Color fundus photograph.
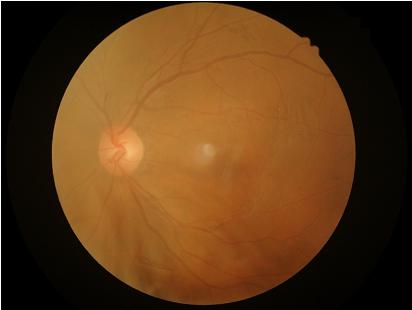 Vessels and details are hard to distinguish.
Overall quality is poor; the image is difficult to grade.
There is over- or under-exposure or a color cast.
No noticeable blur.